Age 59; axial length (AL): 22.53 mm; camera: Topcon TRC-NW400; IOP 16 mmHg (non-contact tonometry); 30° FOV.
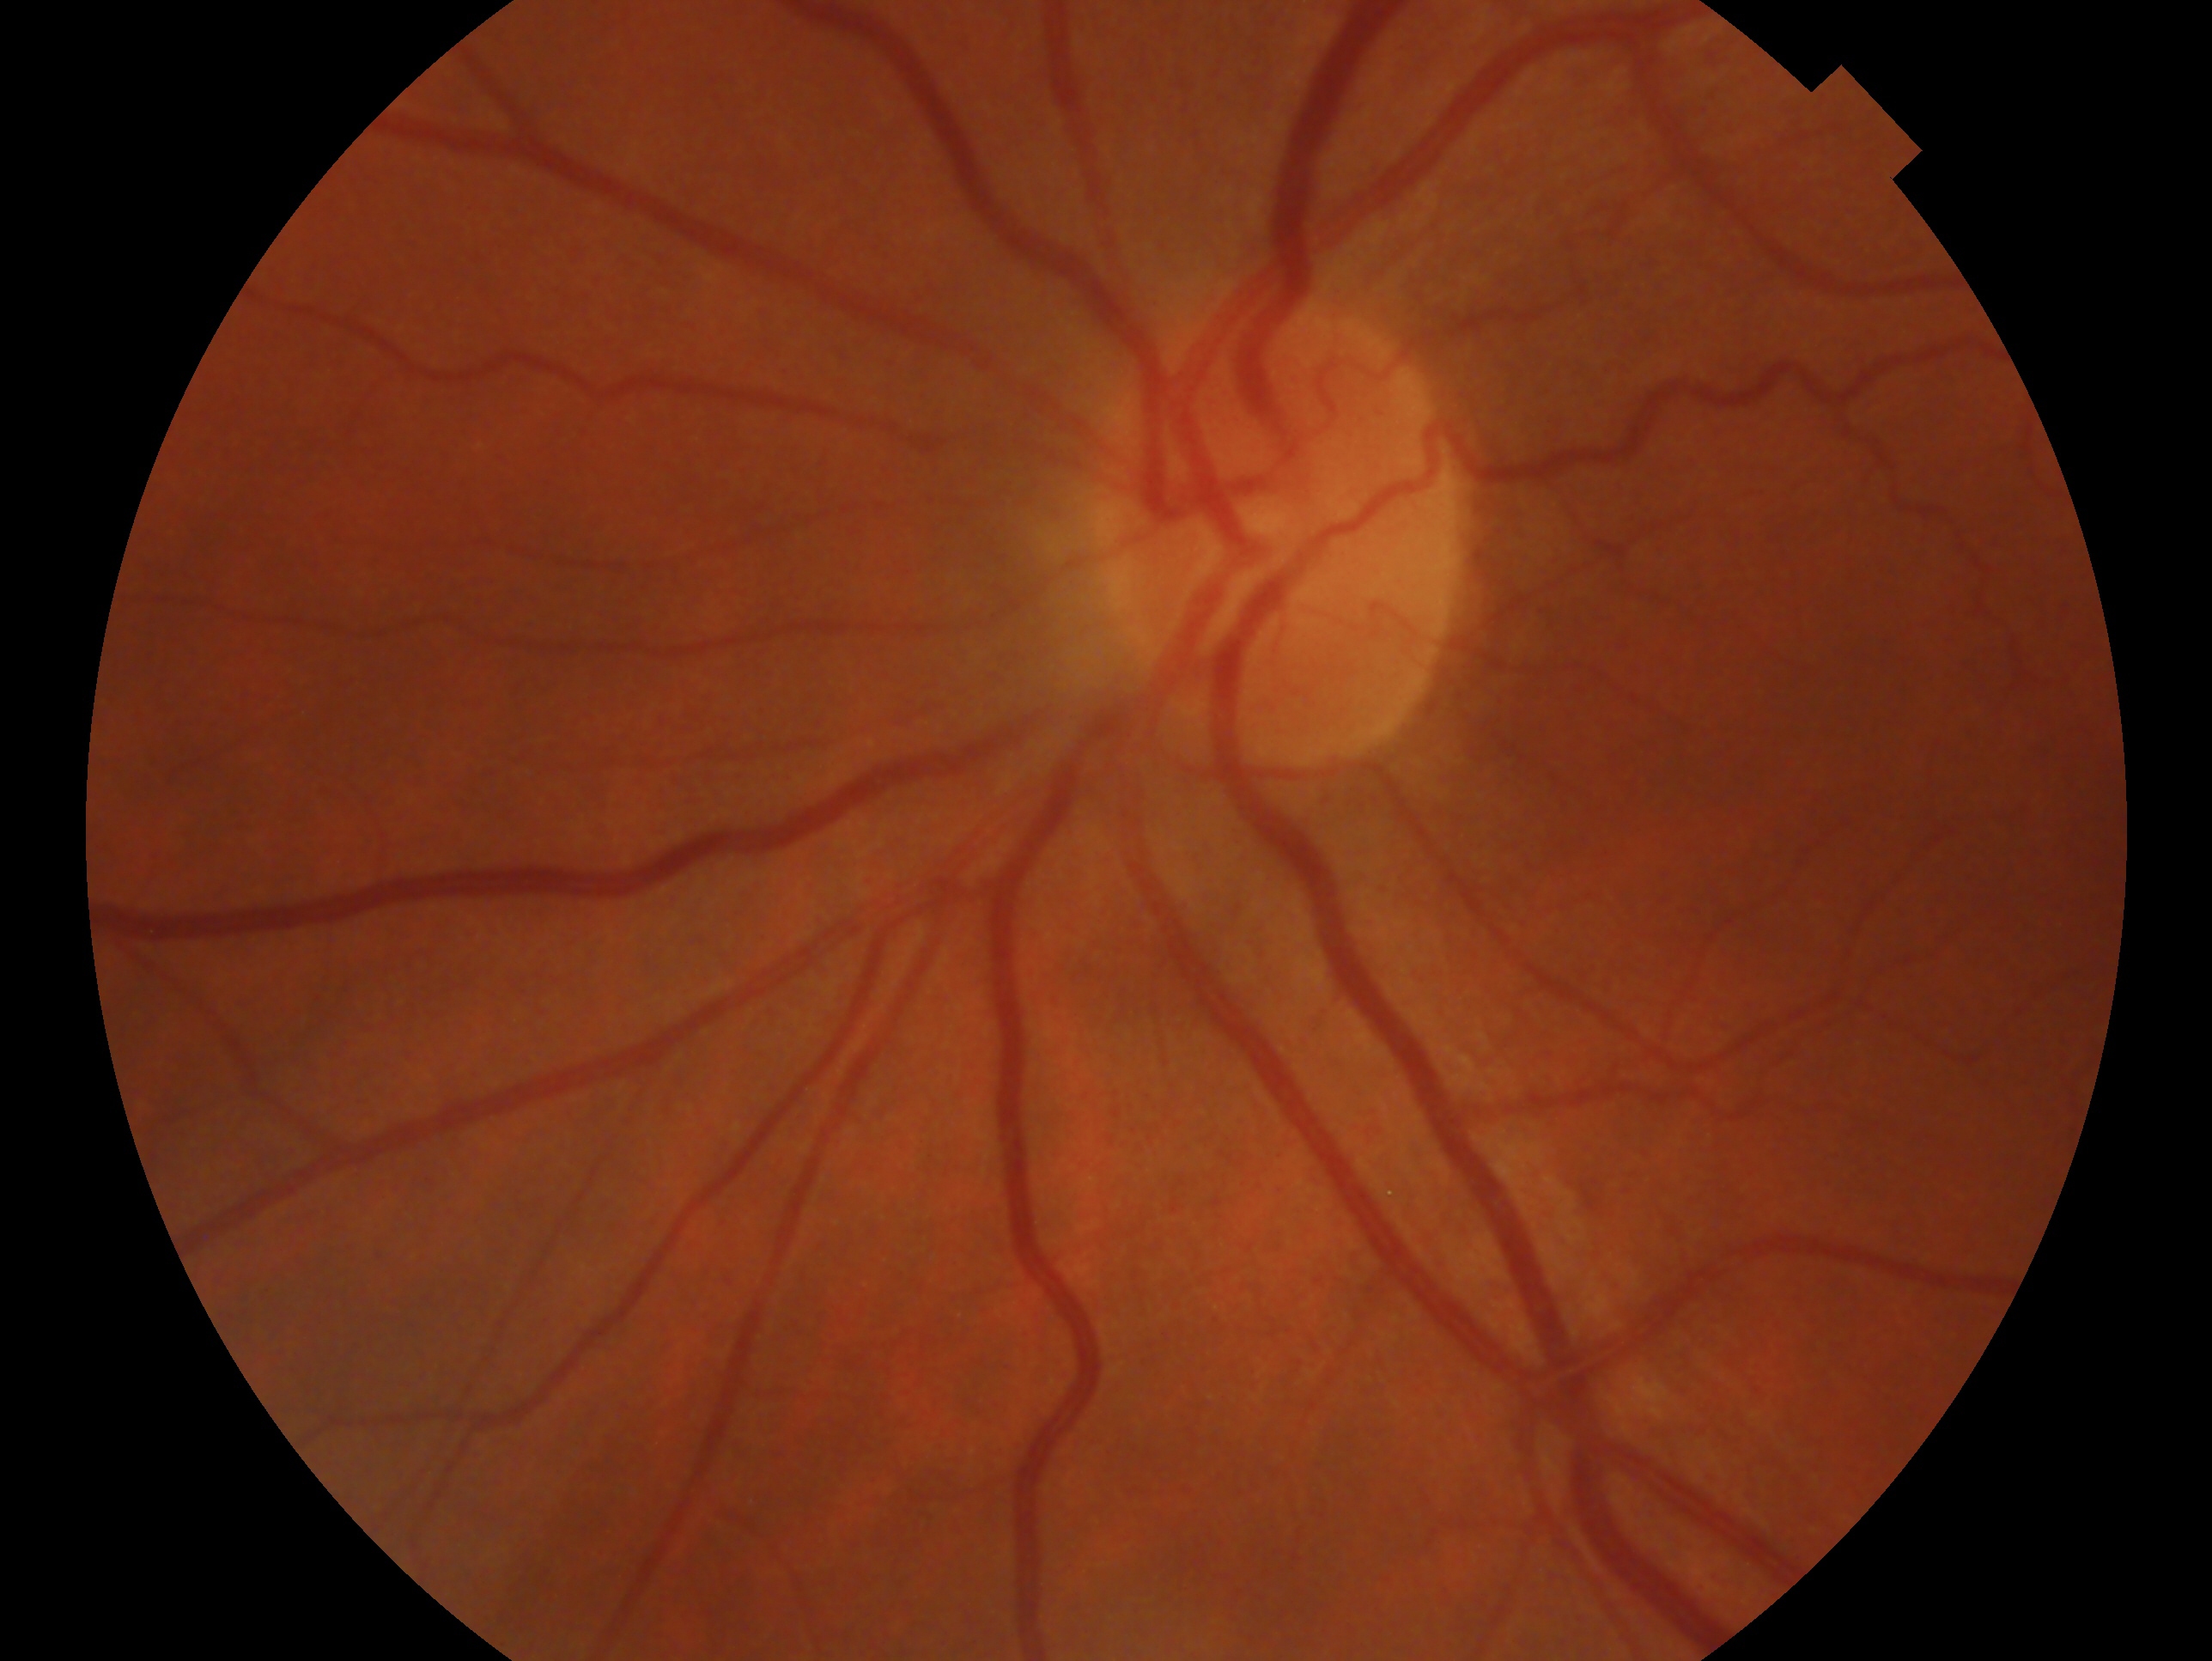

The image shows the OS. Diagnosis: negative for glaucoma.